FOV: 45 degrees — 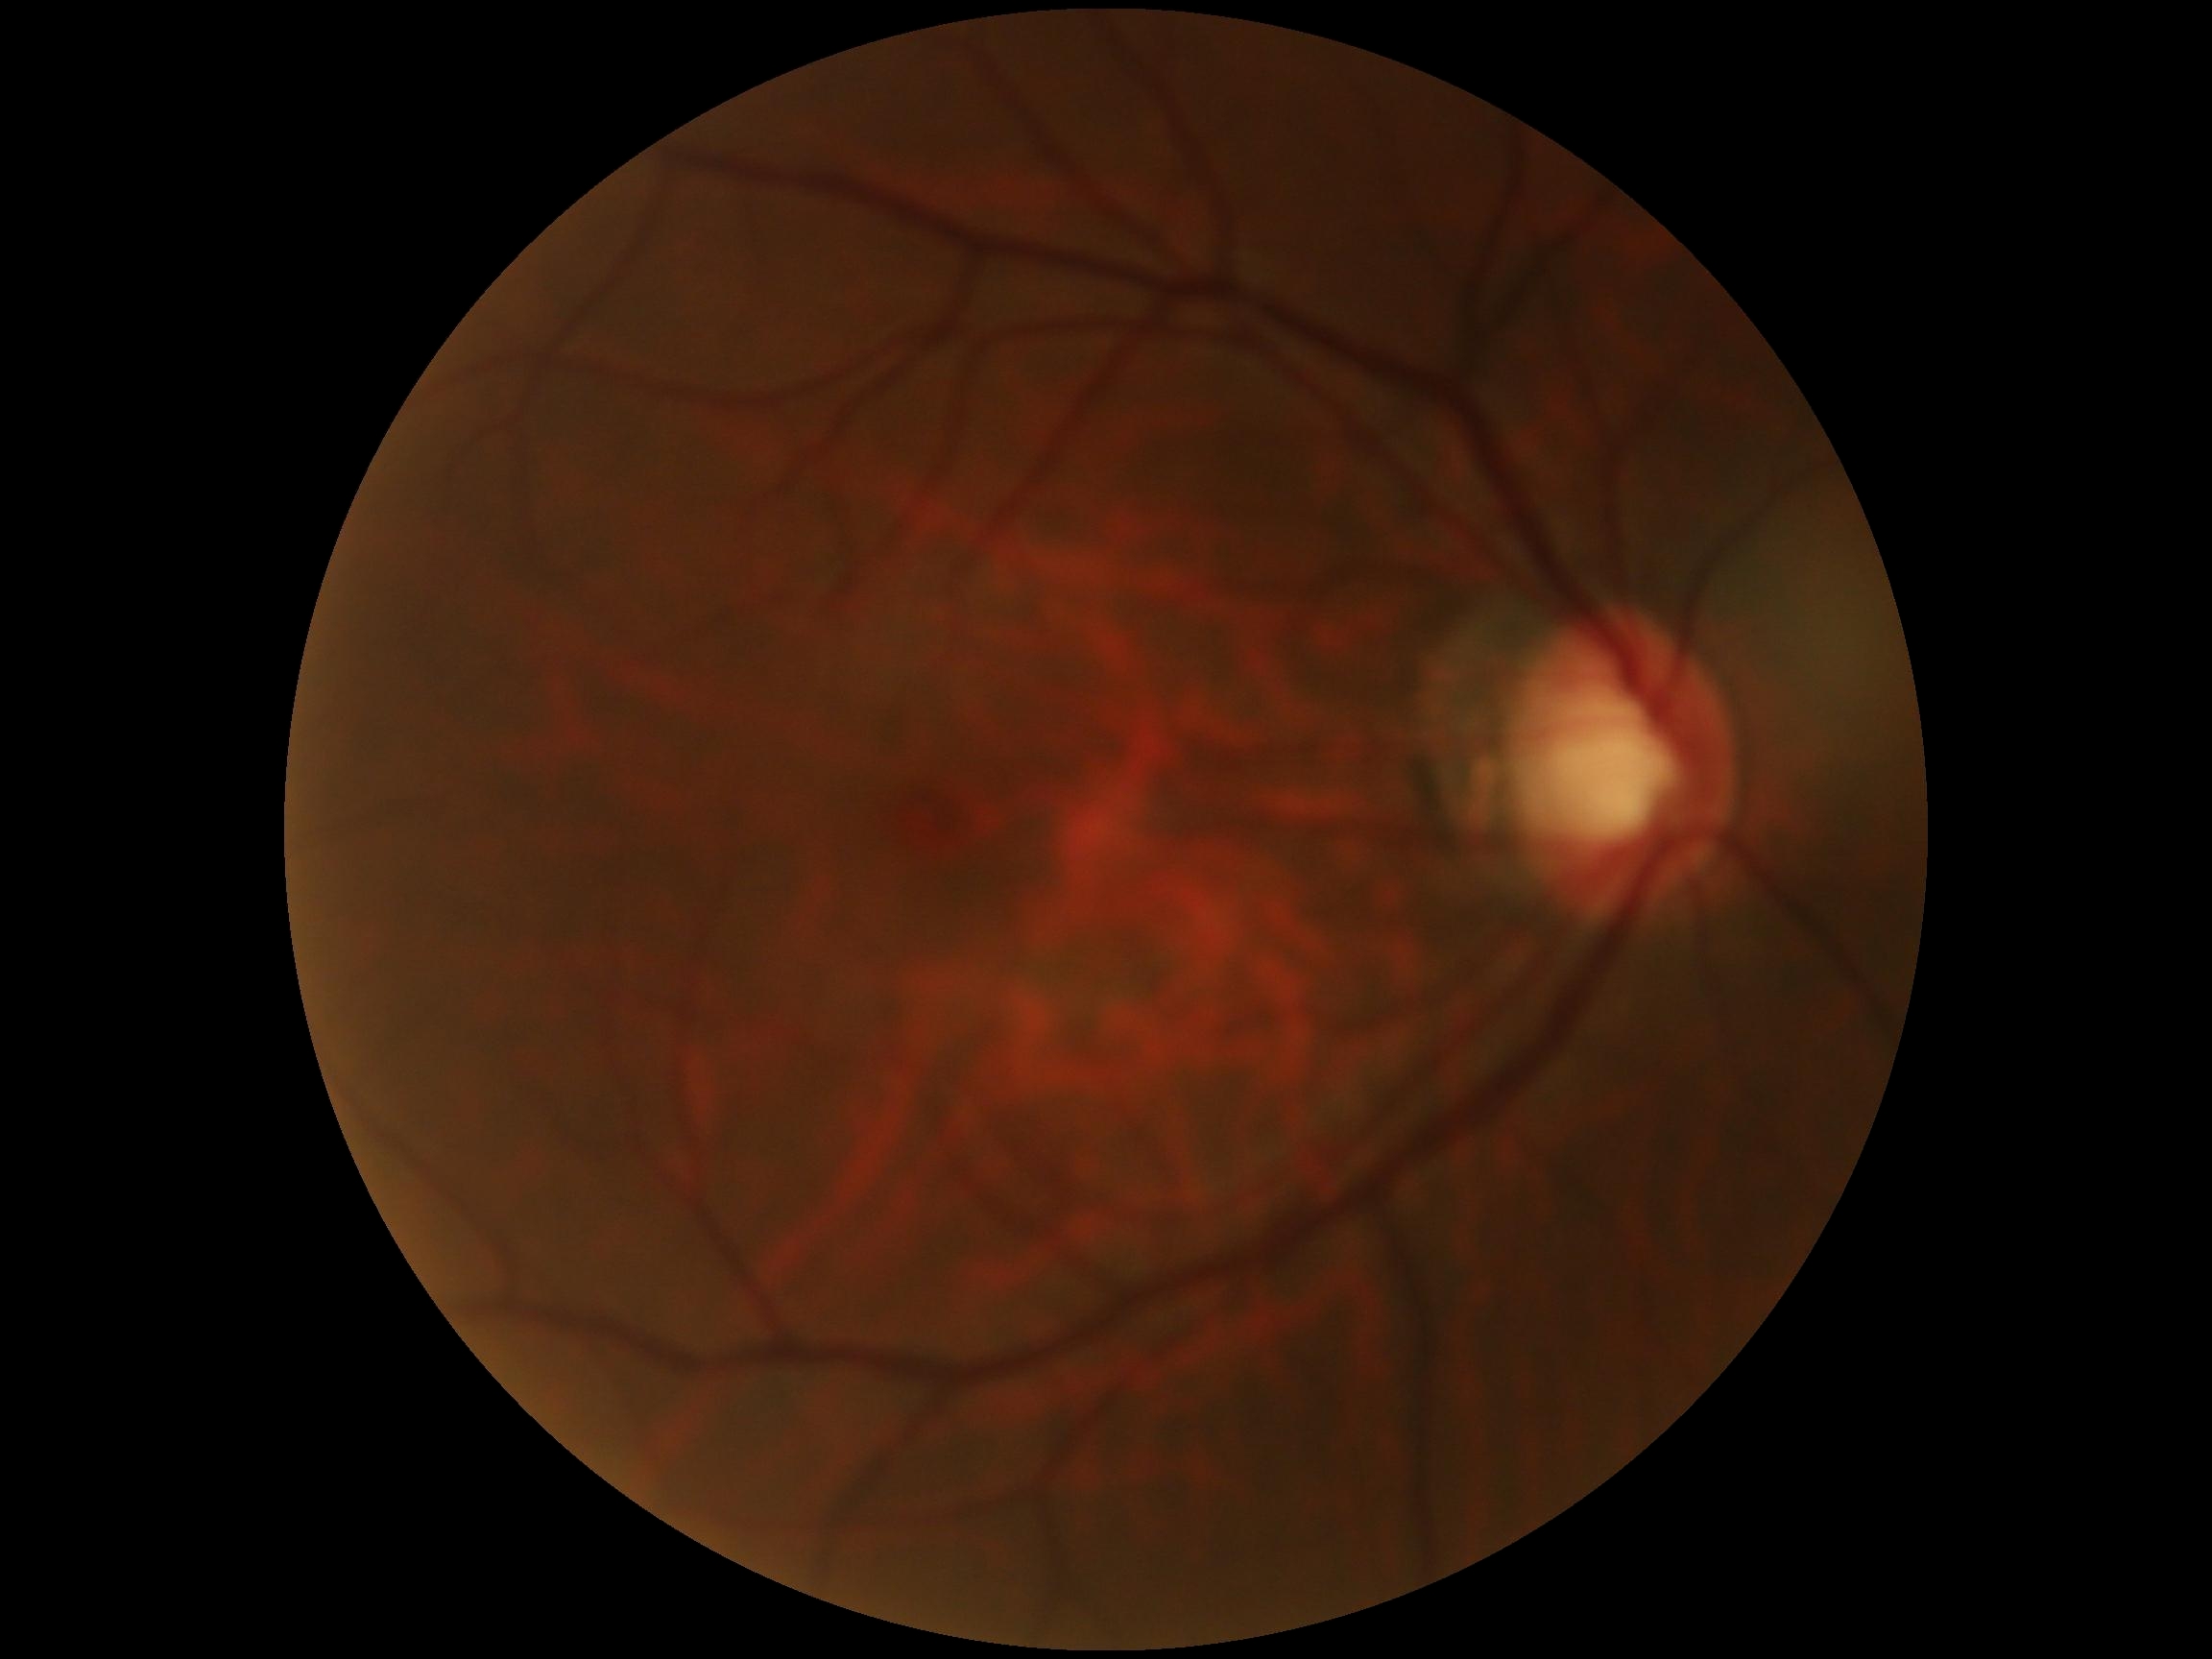

DR severity: 0/4.